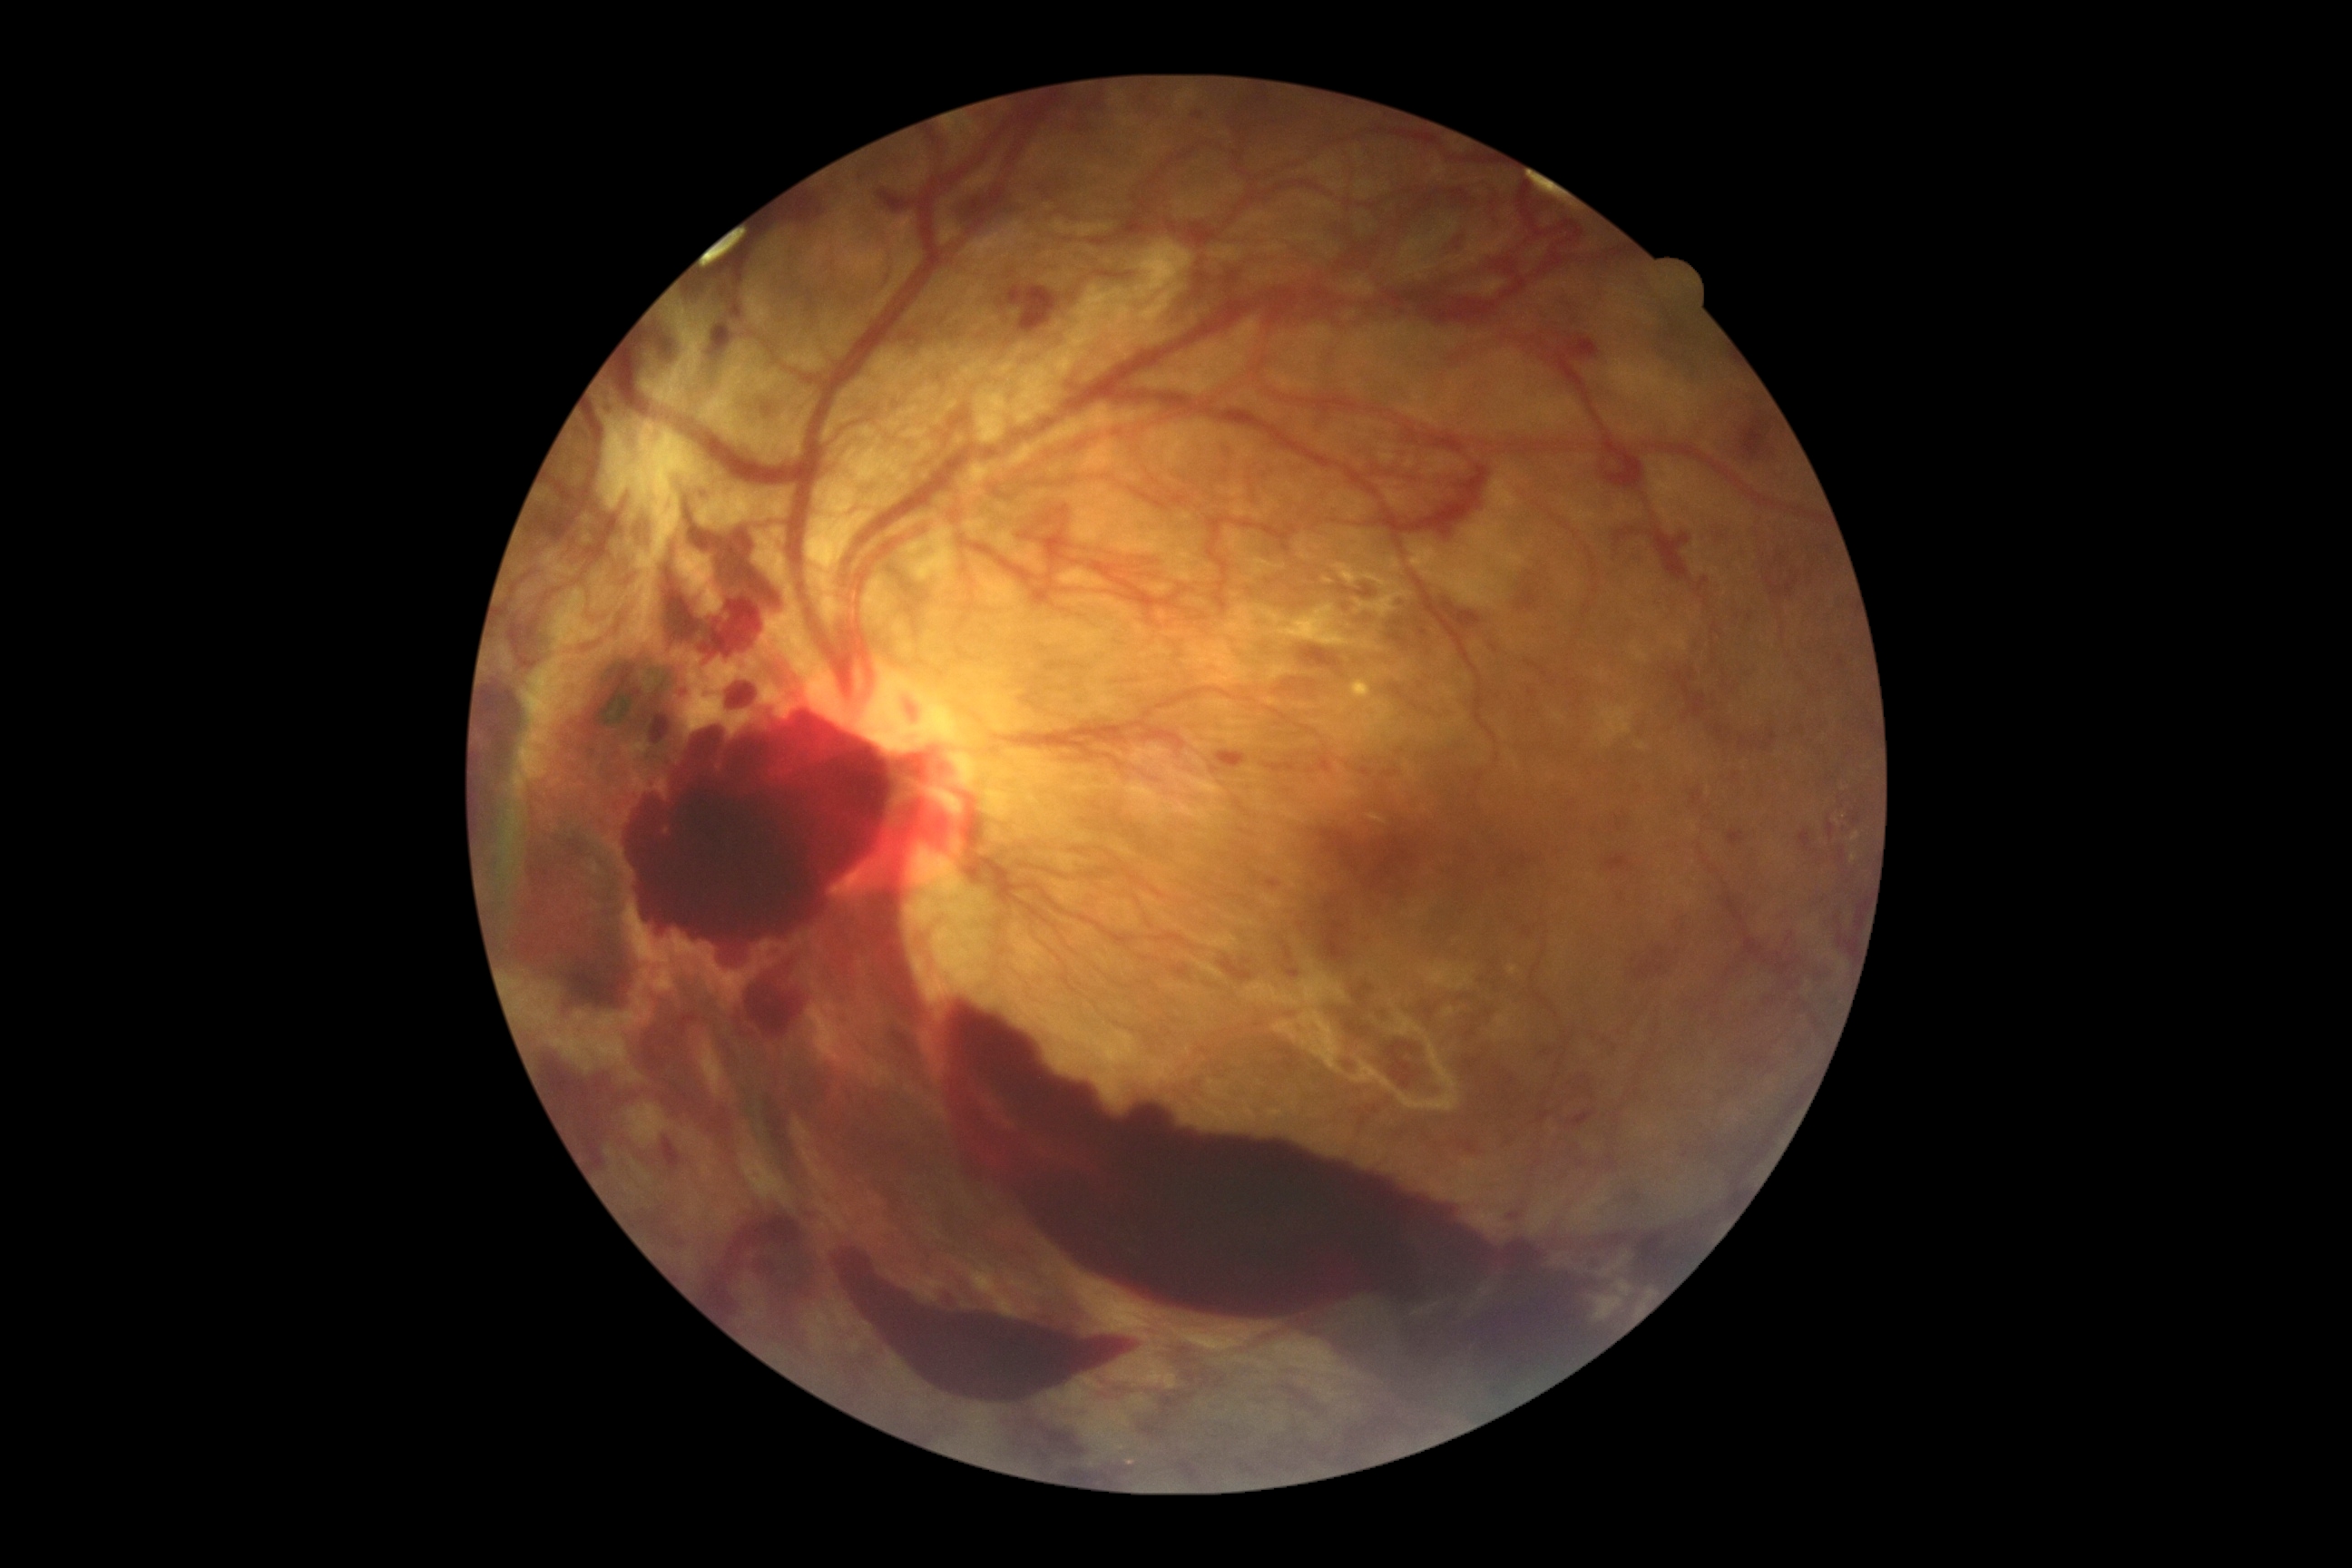
Diabetic retinopathy grade: proliferative diabetic retinopathy (4) — neovascularization and/or vitreous/pre-retinal hemorrhage.